45° field of view: 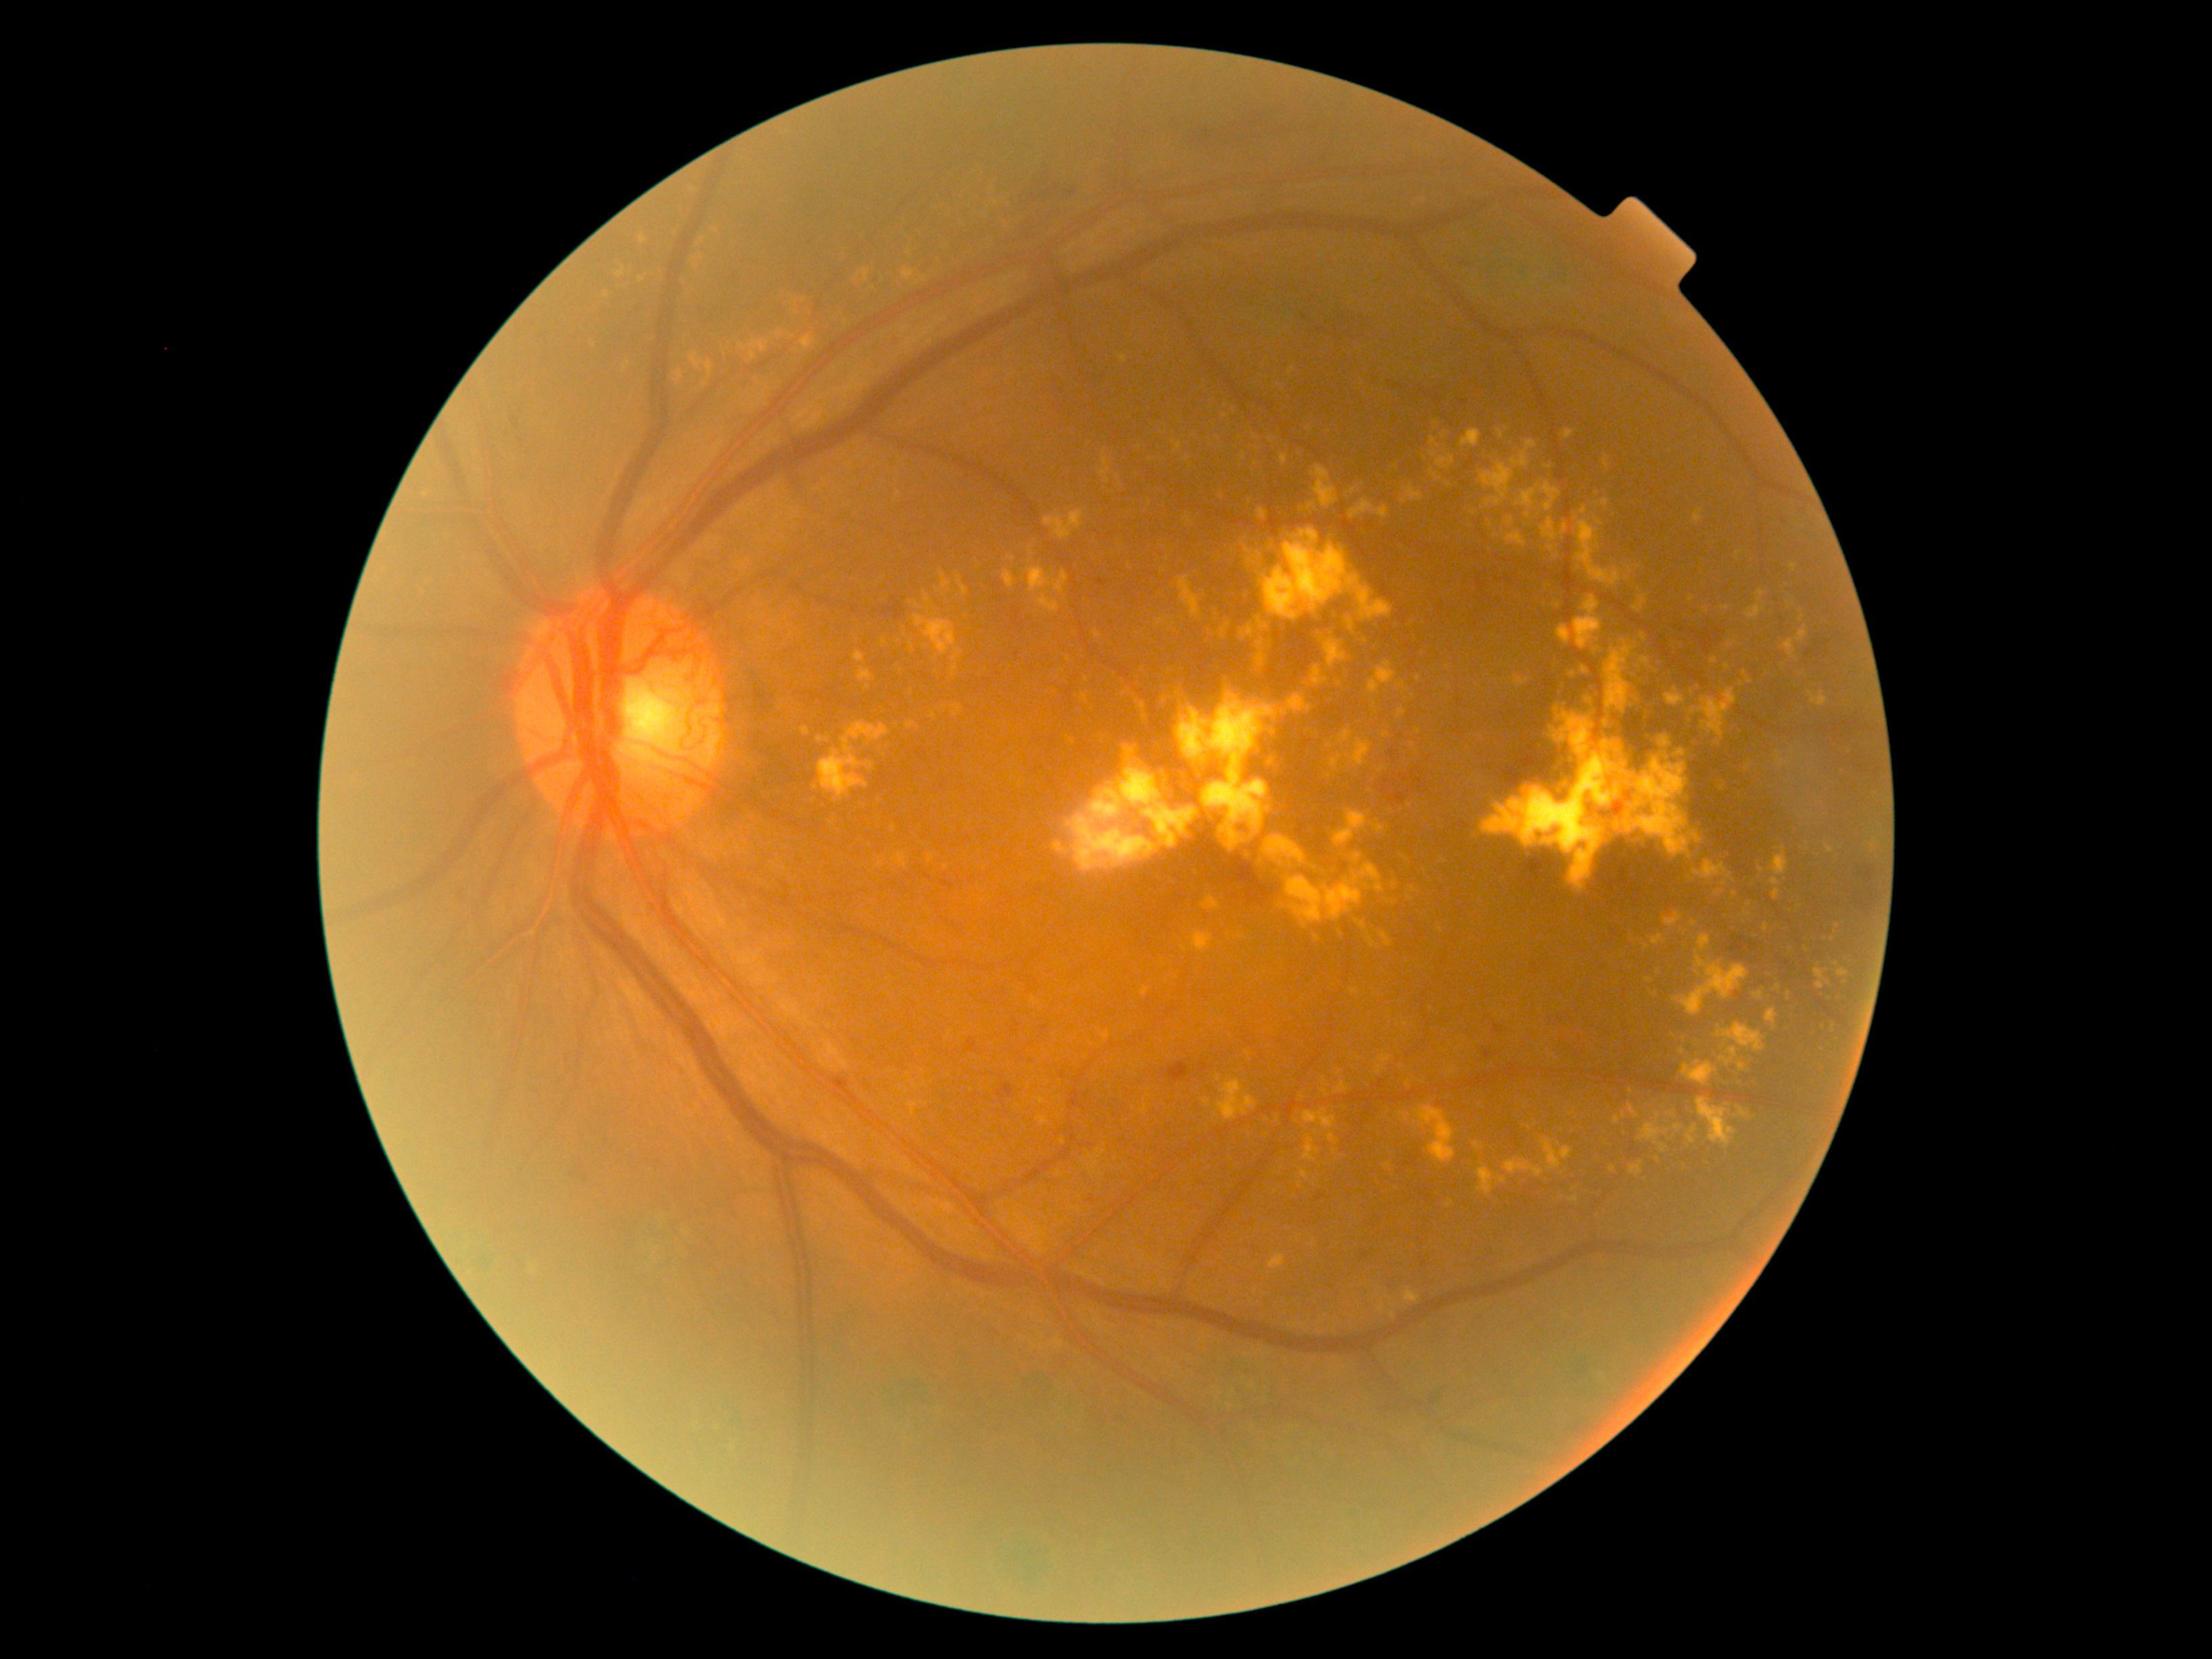

{"partial":true,"dr_grade":4,"dr_grade_name":"PDR","lesions":{"ex":[[1333,810,1371,846],[1771,878,1782,887],[1790,898,1799,912],[1219,758,1227,768],[1189,930,1215,954],[1380,933,1393,947],[1004,570,1016,589],[1745,677,1753,685],[1244,546,1250,554],[1100,455,1111,485],[1523,1127,1531,1132],[1066,746,1197,871]],"ex_small_approx":[[1272,733],[1762,871],[1161,573],[884,758],[1598,1158],[911,646],[1406,1025],[702,240]]}}